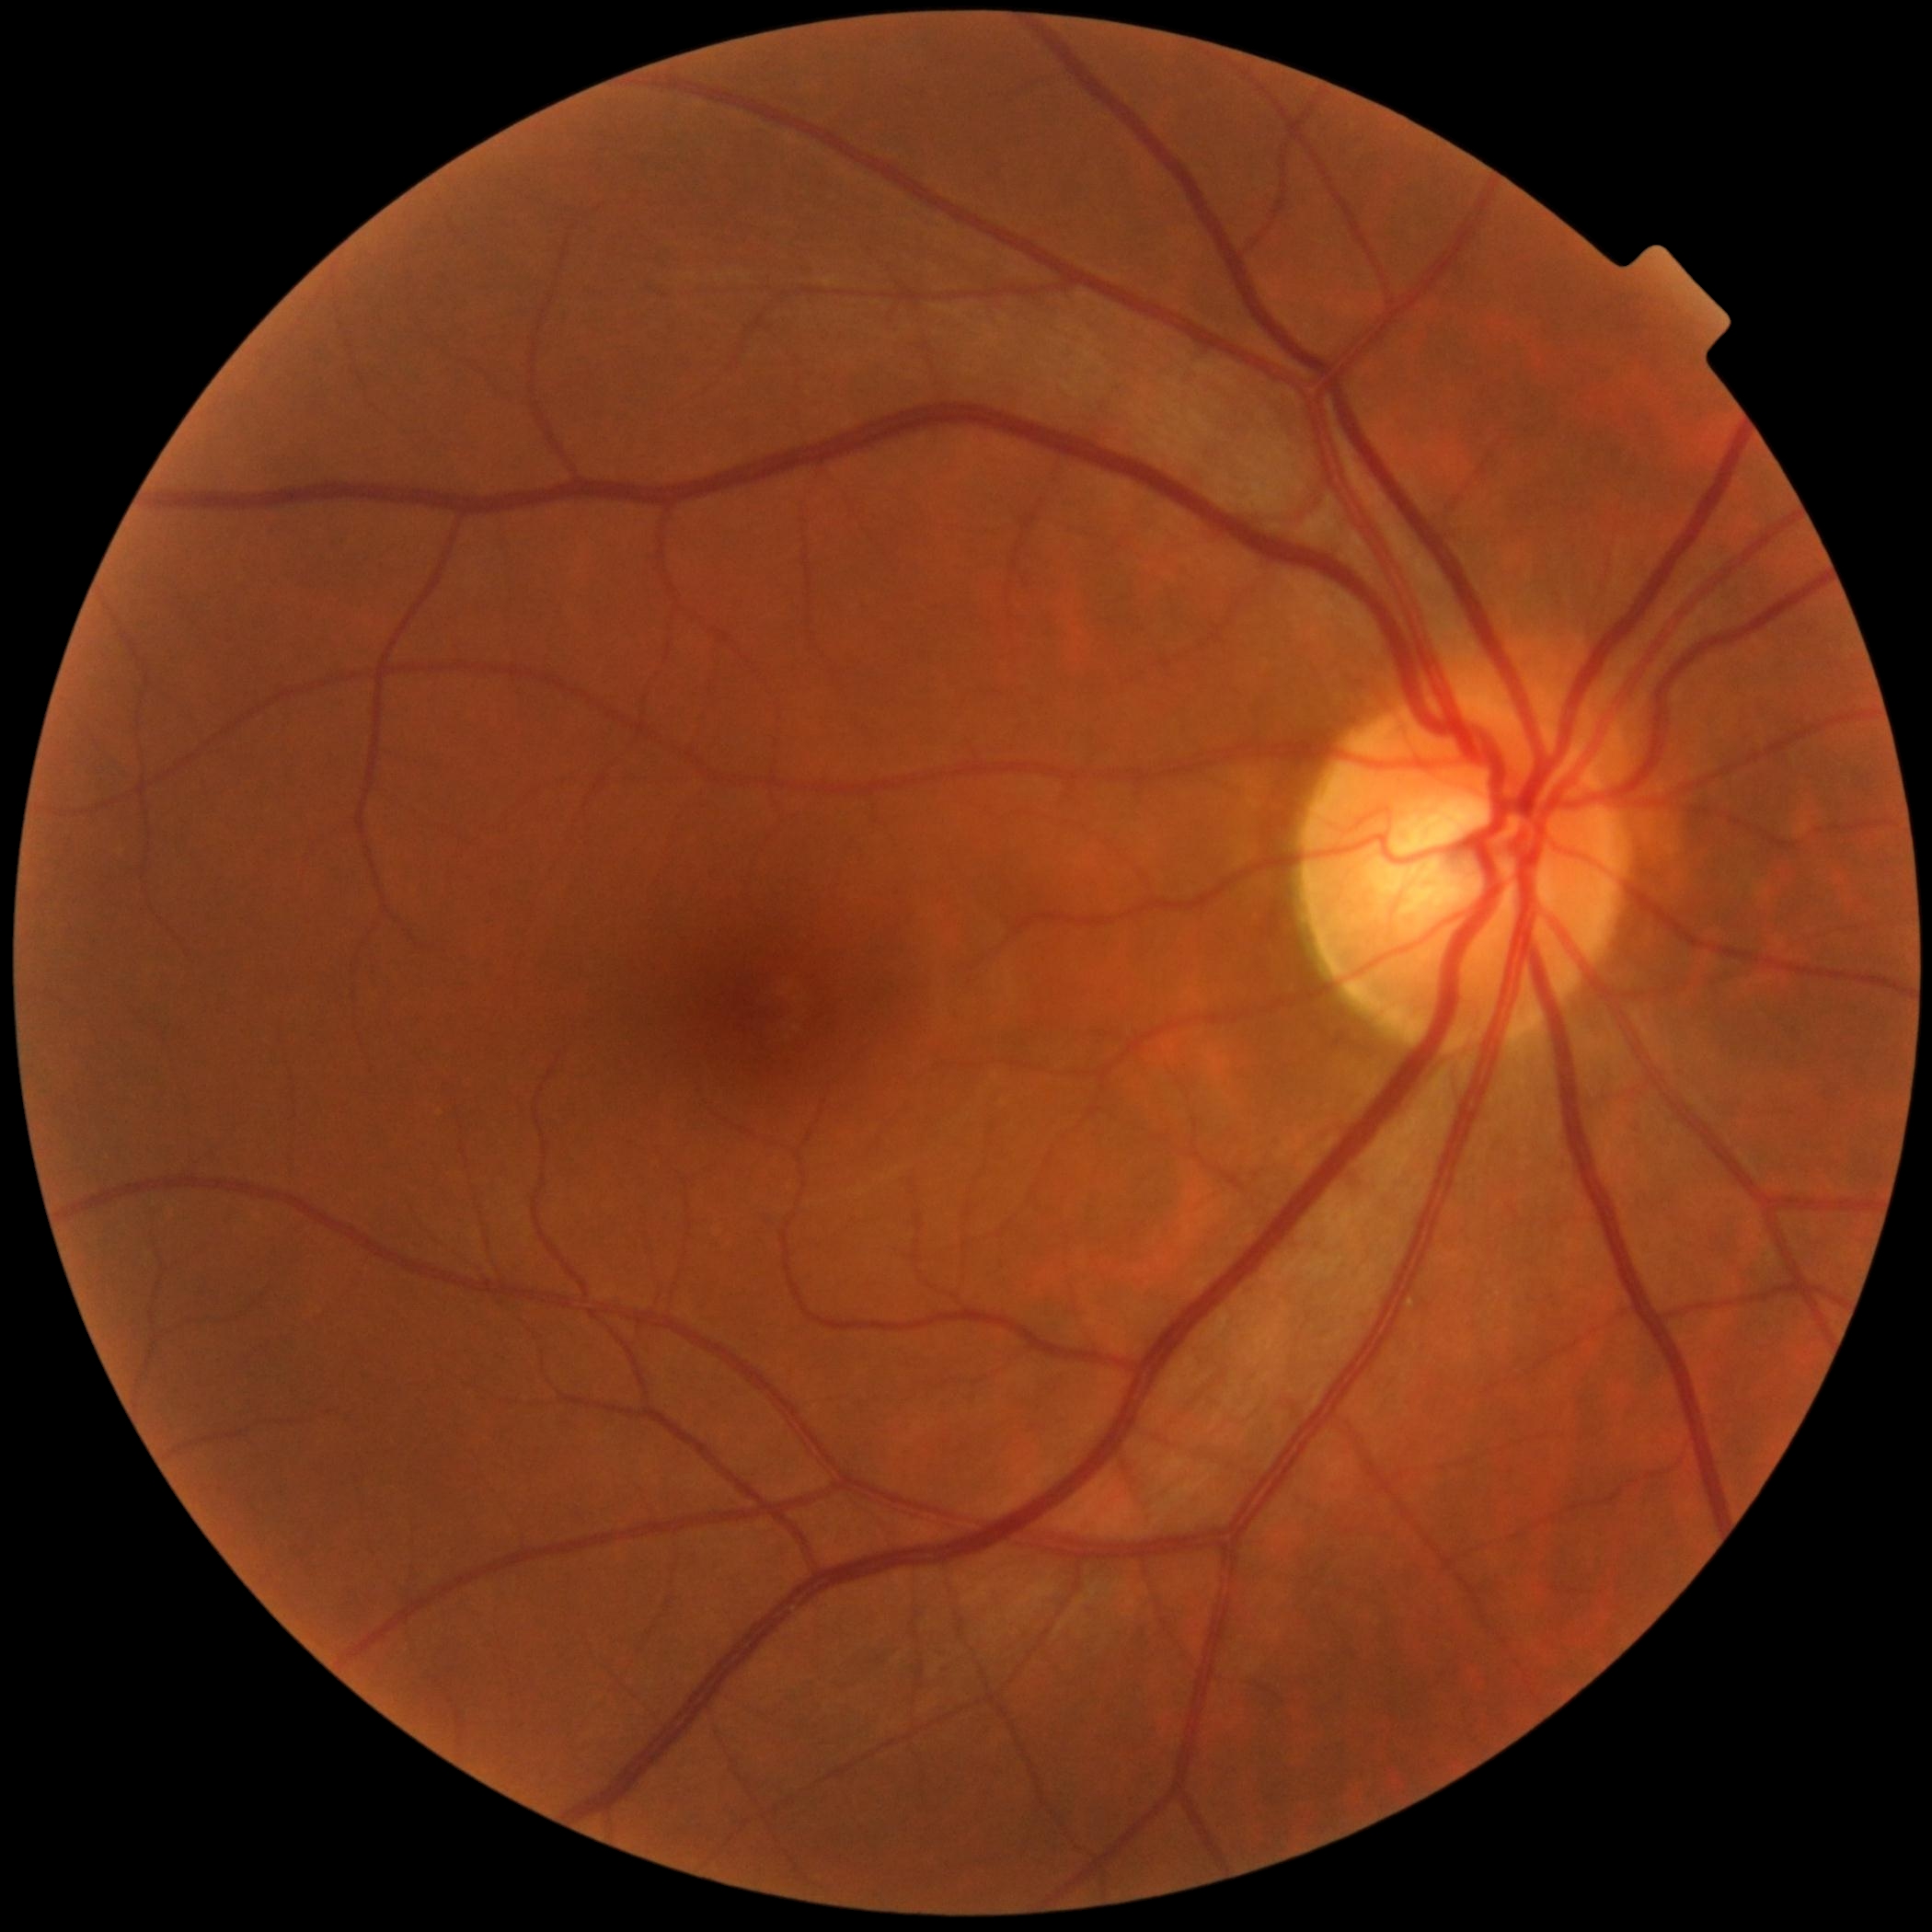

DR impression@no apparent DR, diabetic retinopathy grade@no apparent diabetic retinopathy (0) — no visible signs of diabetic retinopathy.